Nonmydriatic fundus photograph · 848 x 848 pixels — 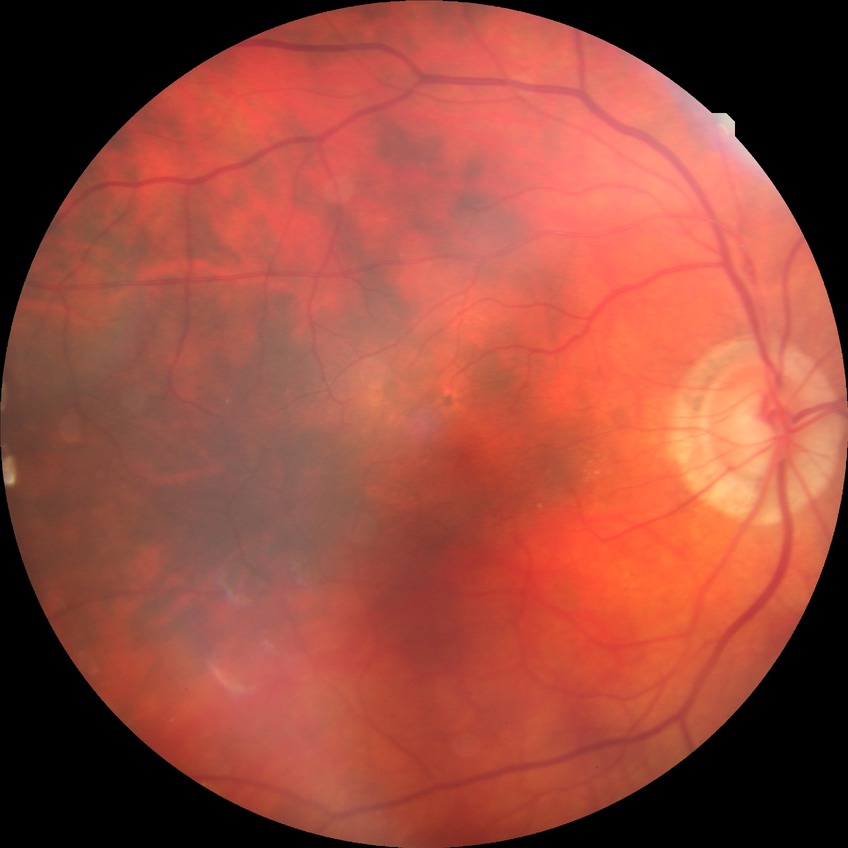
Diabetic retinopathy (DR) is no diabetic retinopathy (NDR).